1659 by 2212 pixels, color fundus photograph.
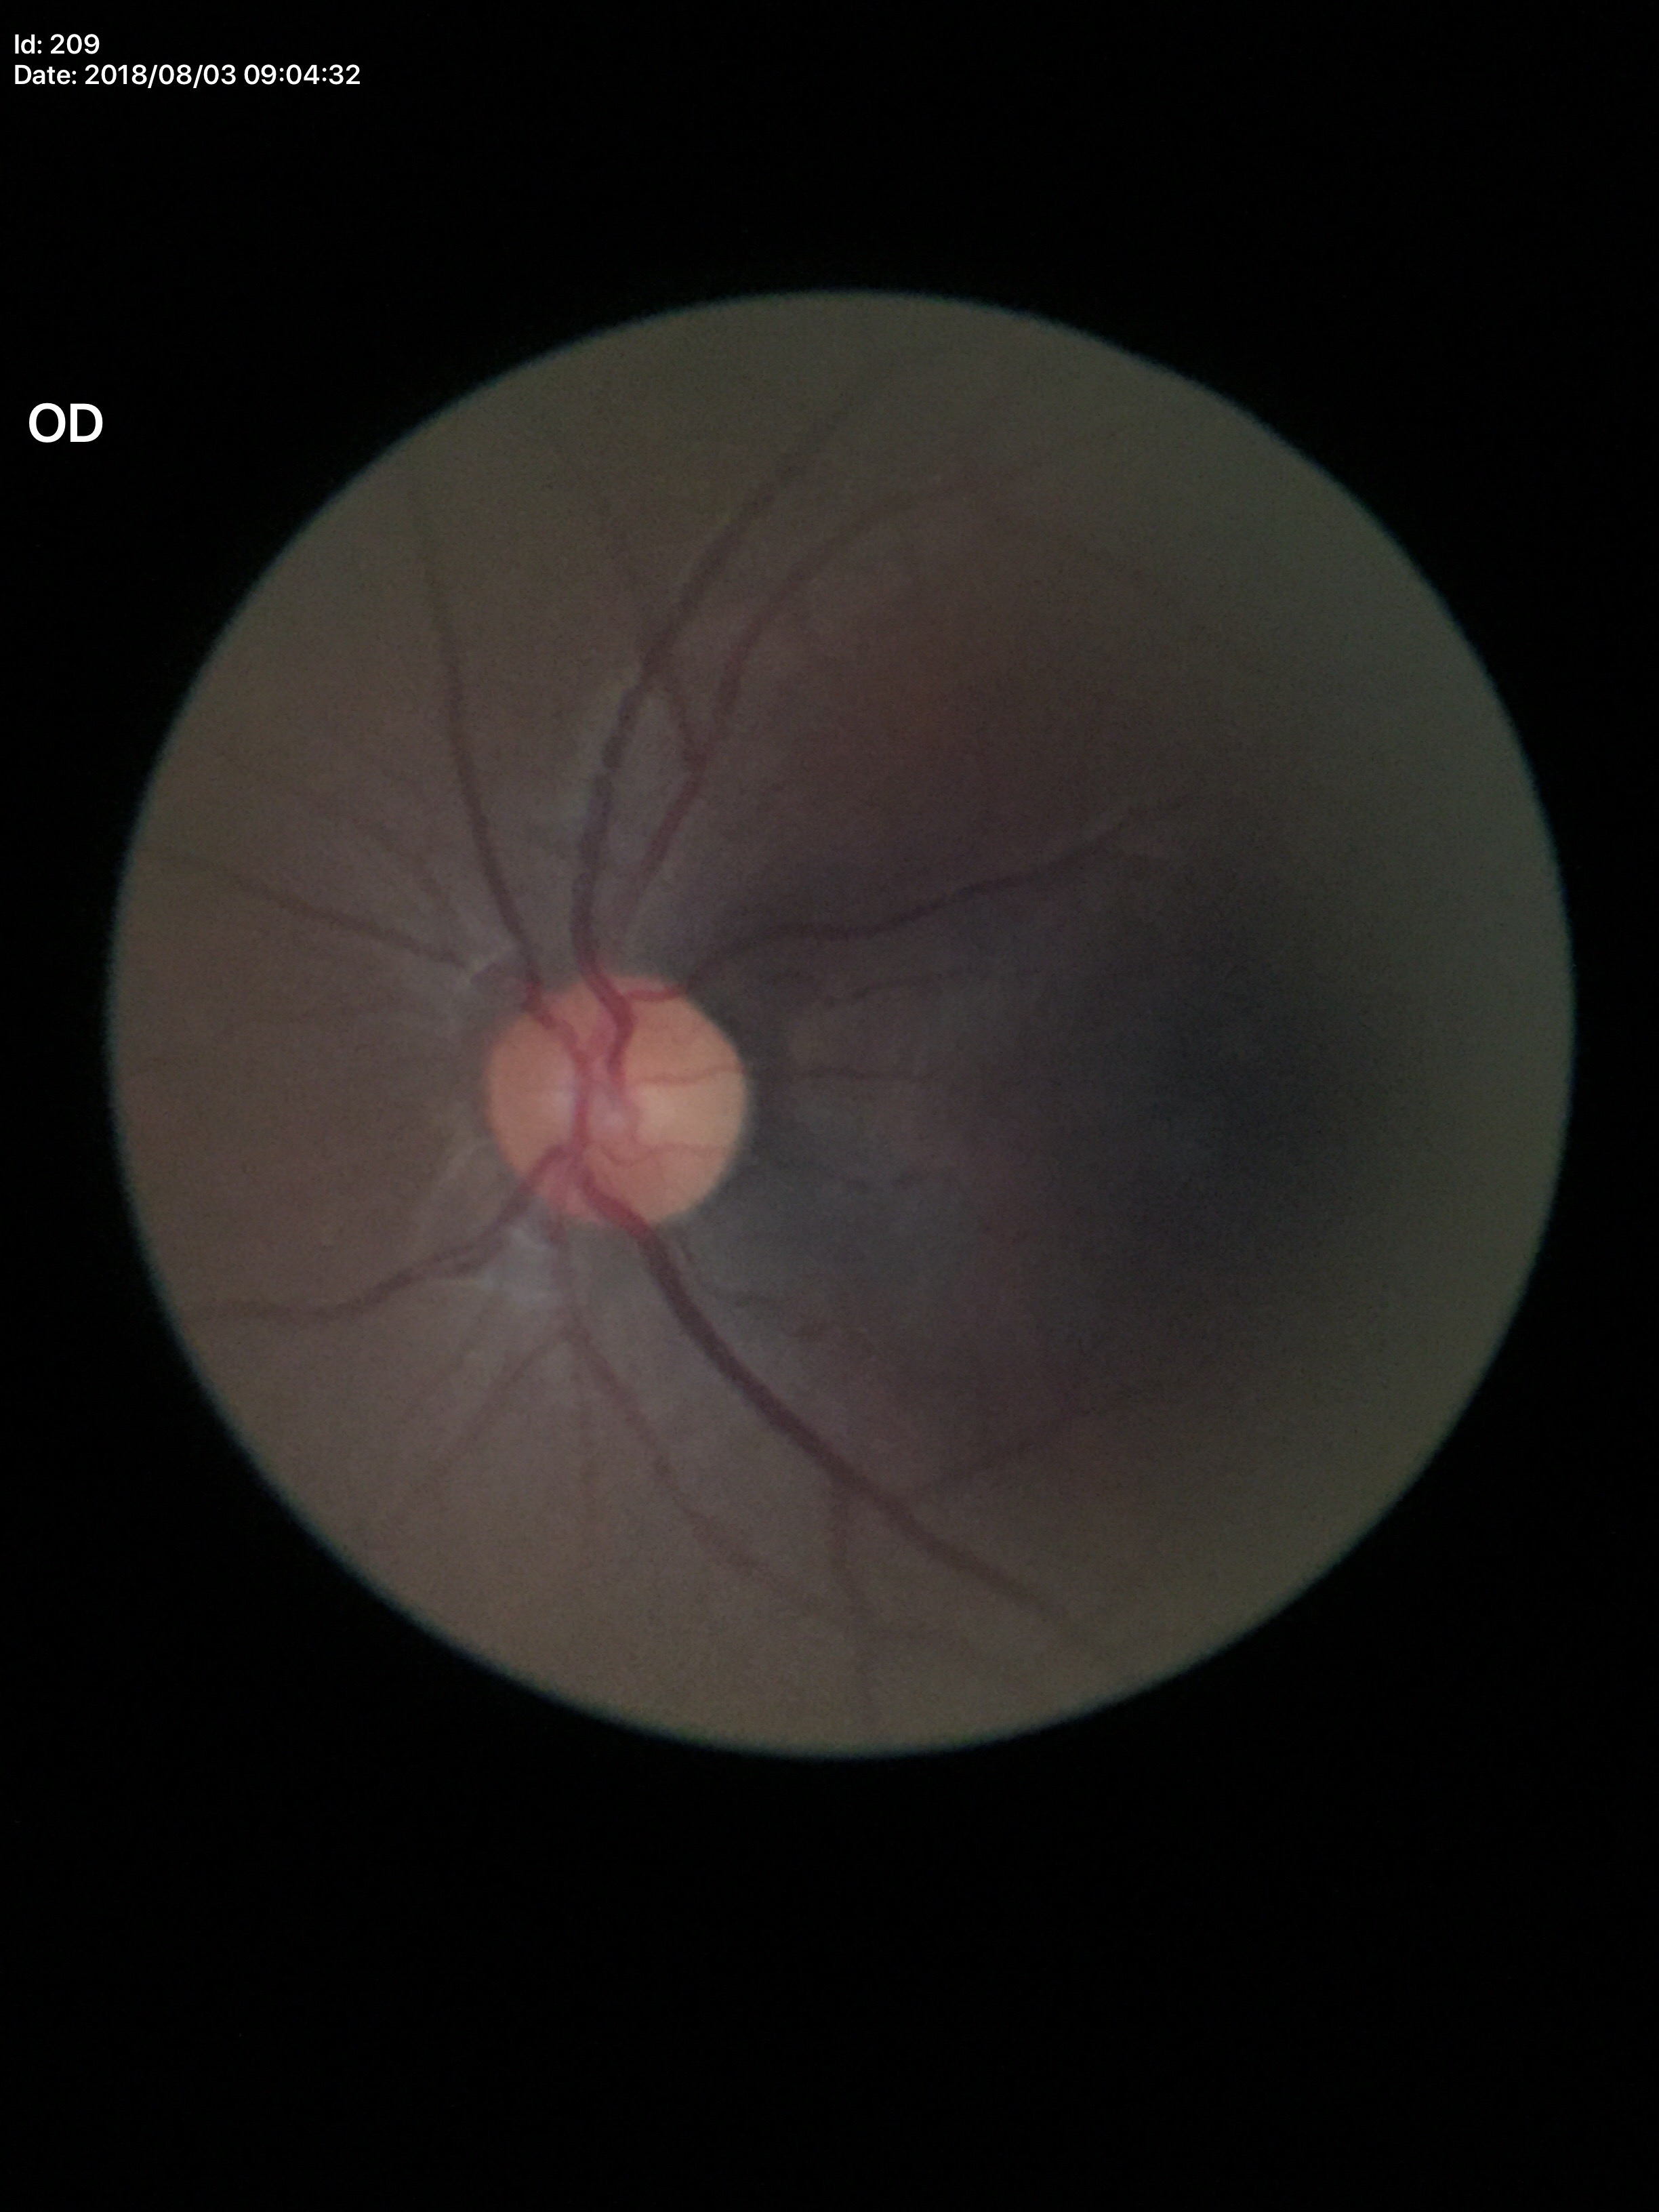 Negative for glaucoma suspicion (unanimous normal call). Vertical cup-to-disc ratio of 0.31. Horizontal cup-to-disc ratio of 0.34.